Wide-field contact fundus photograph of an infant: 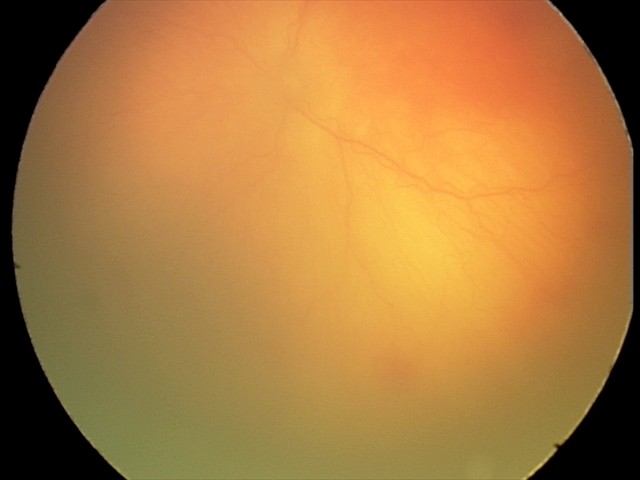

Screening examination consistent with aggressive retinopathy of prematurity.
With plus disease.